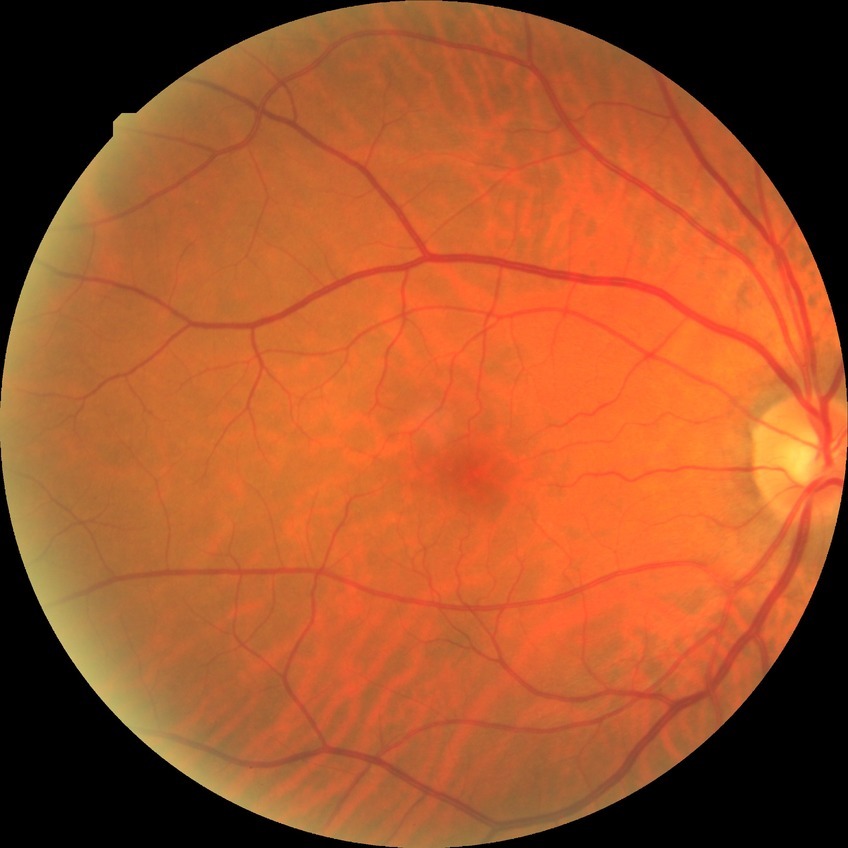

  davis_grade: SDR